640 by 480 pixels. Wide-field fundus photograph from neonatal ROP screening.
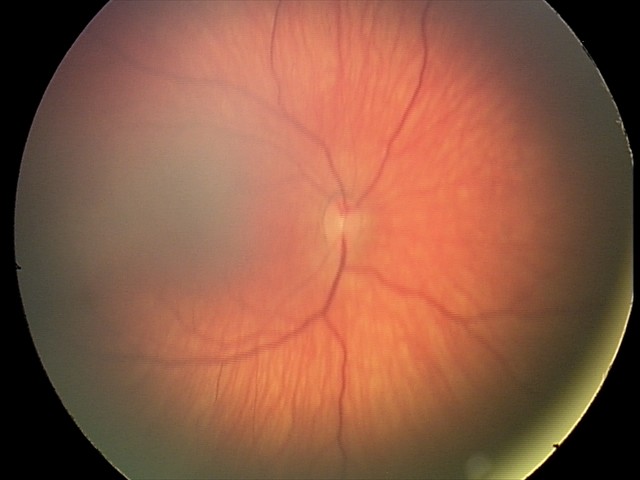
Series diagnosed as retinal hemorrhages.